2352 by 1568 pixels — 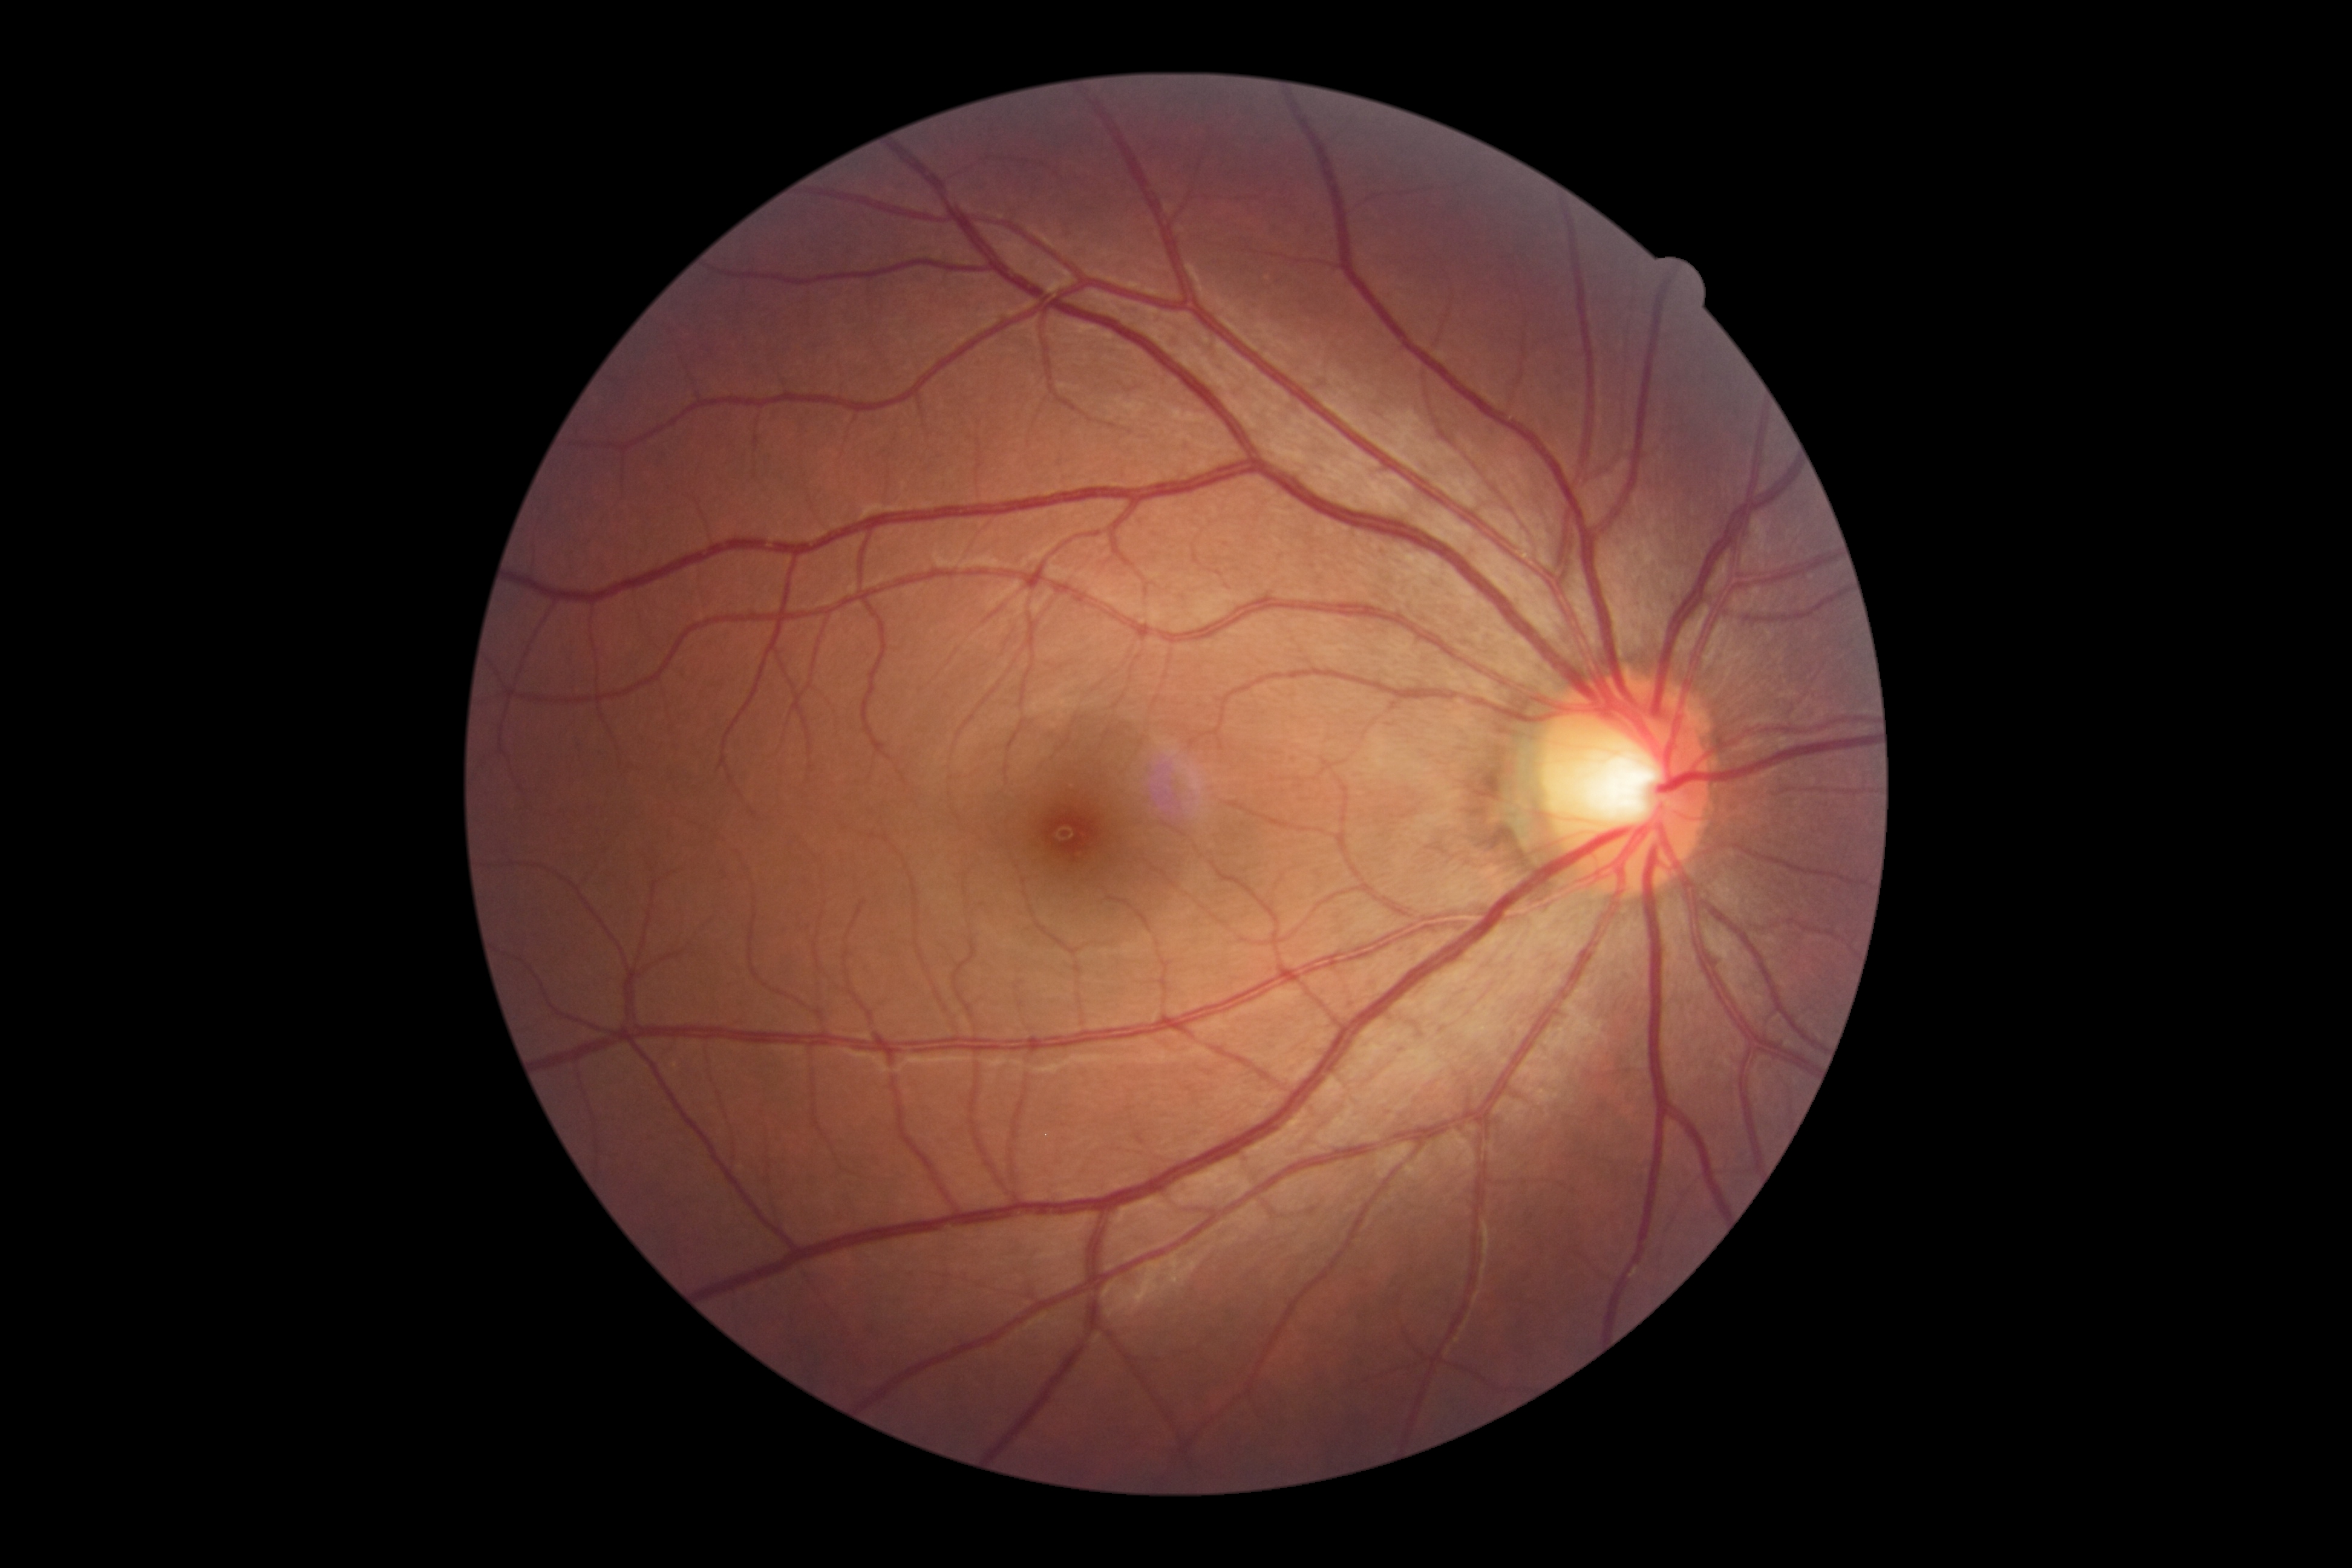

DR severity: grade 0 (no apparent retinopathy).